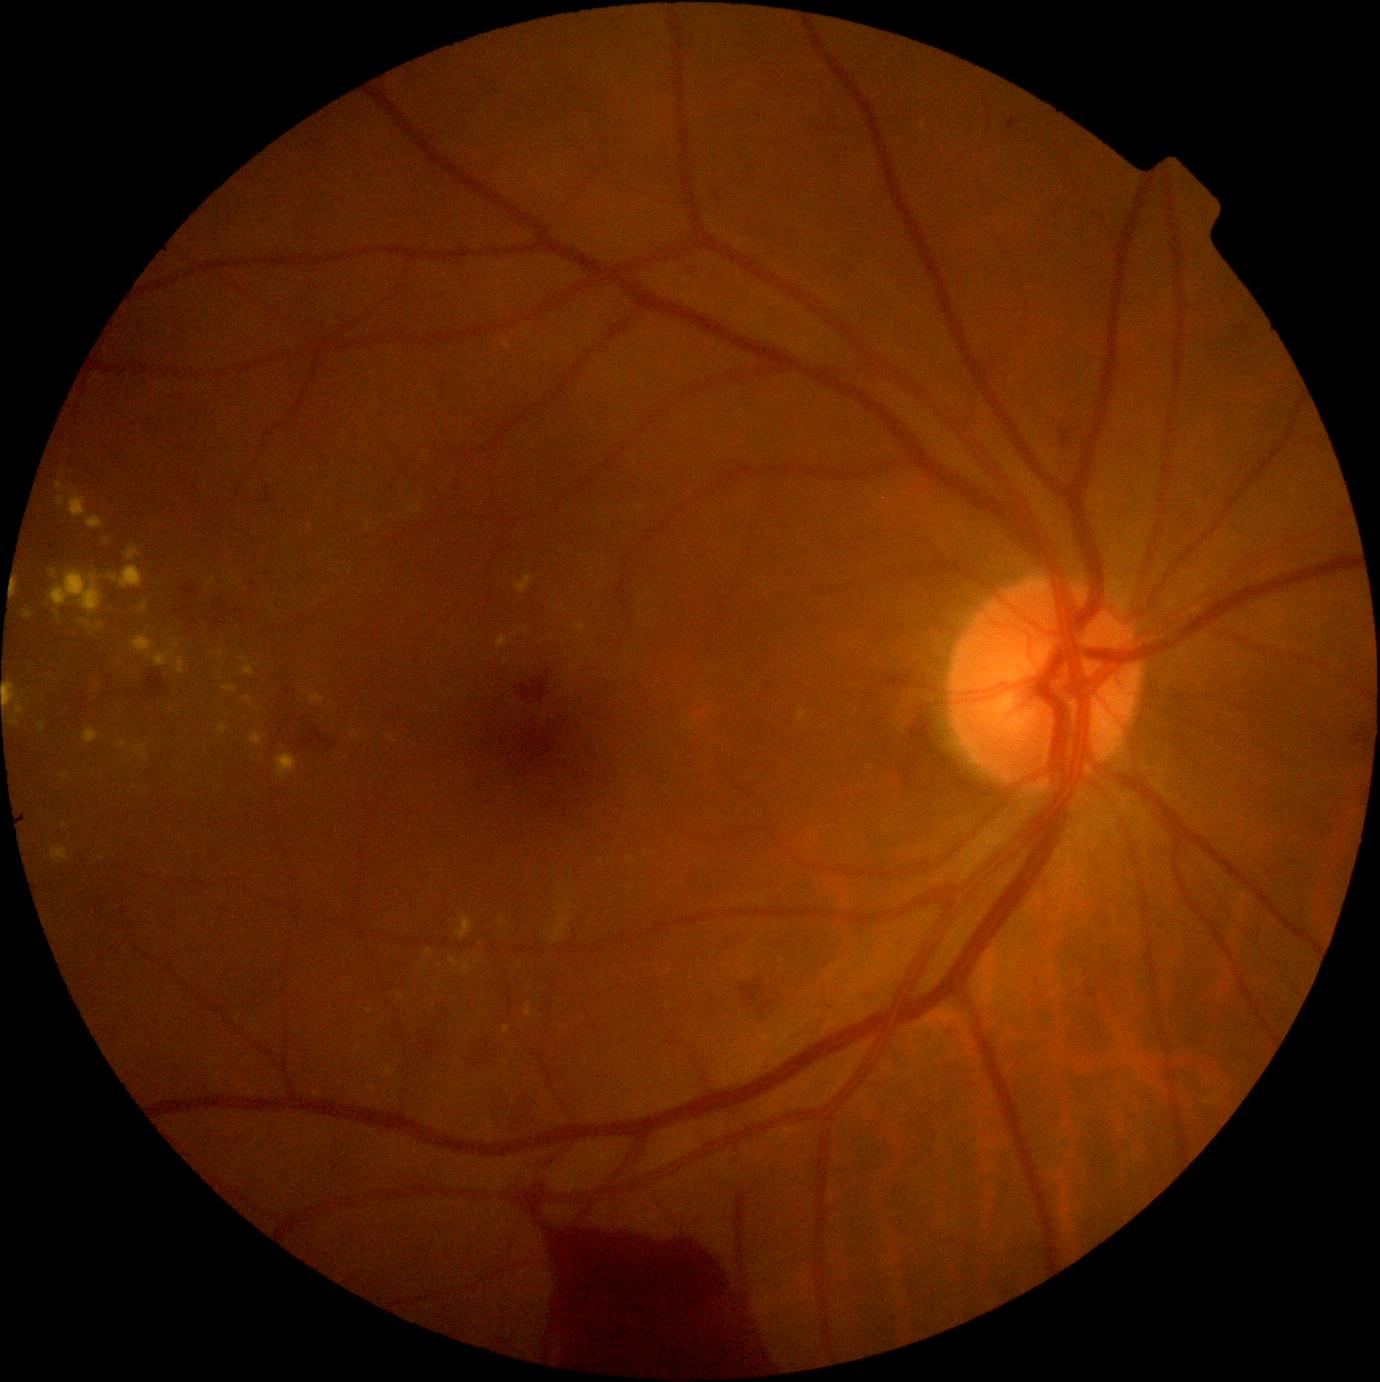
* DR grade — proliferative diabetic retinopathy (4)